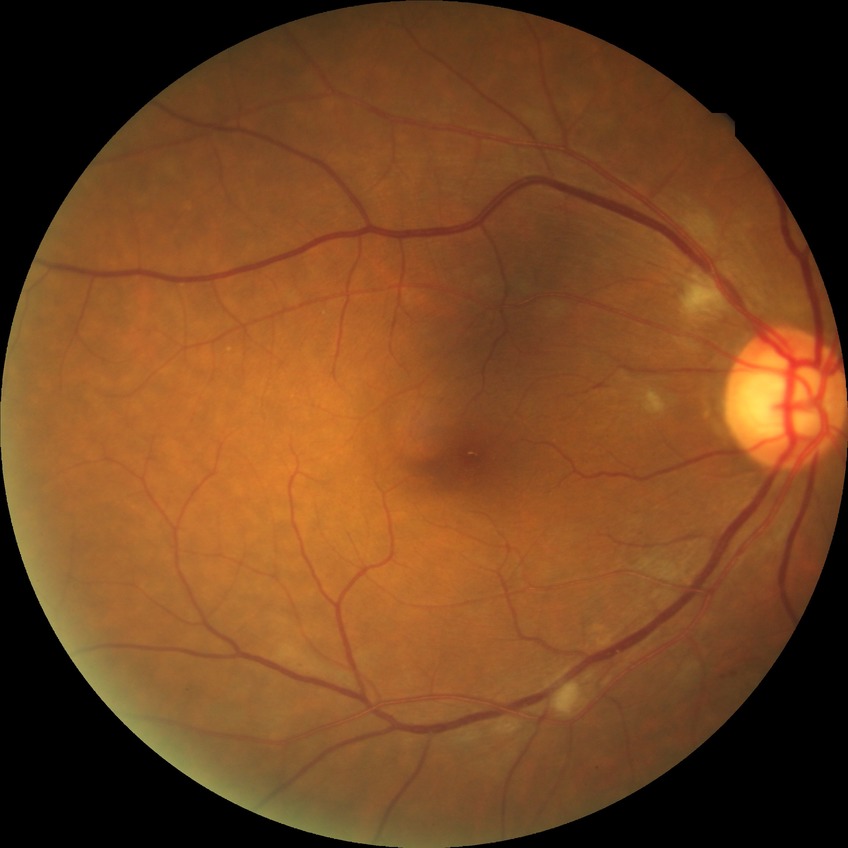

Diabetic retinopathy severity is pre-proliferative diabetic retinopathy.